Fundus photo — 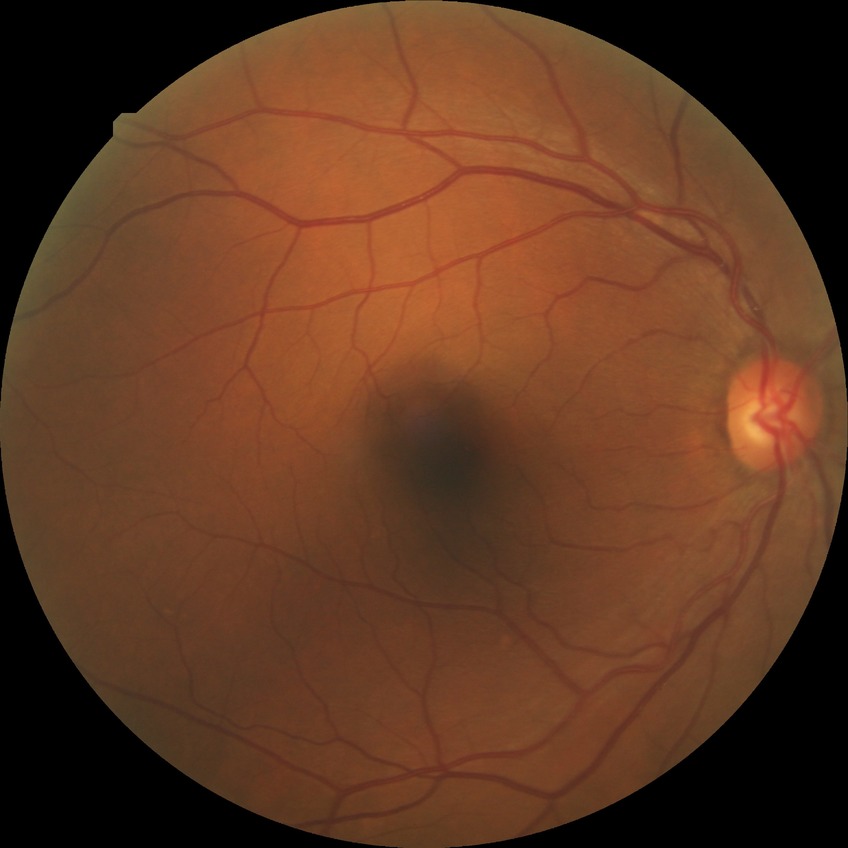

– diabetic retinopathy (DR): no diabetic retinopathy (NDR)